NIDEK AFC-230. 45-degree field of view. 848 x 848 pixels:
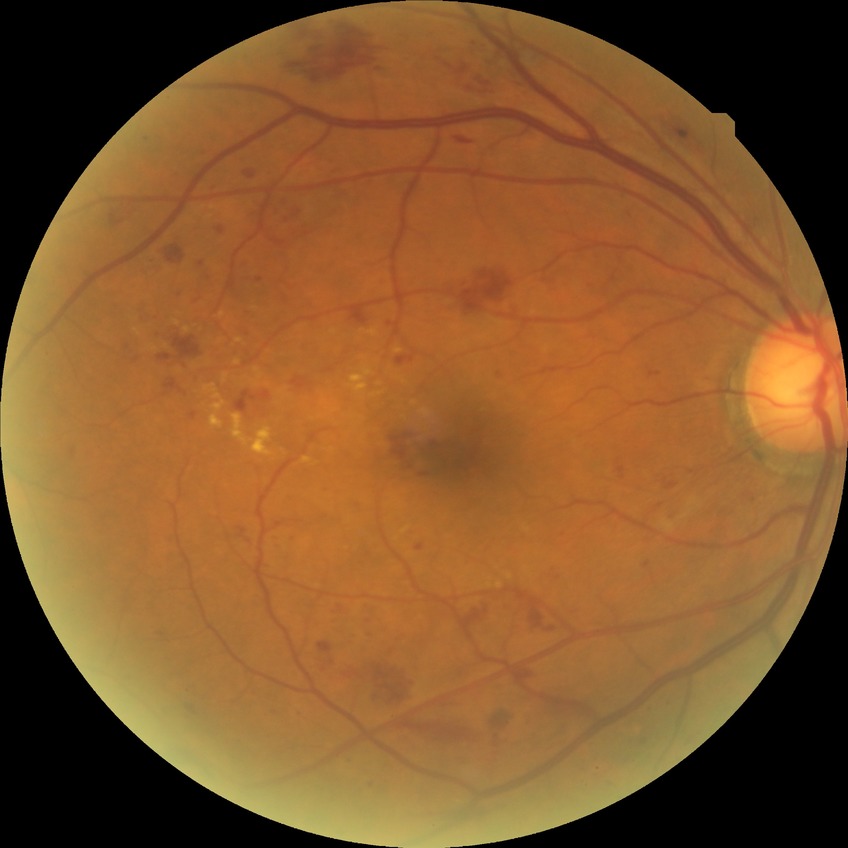

DR grade: SDR.